Camera: Remidio smartphone fundus camera. 1659x2212px
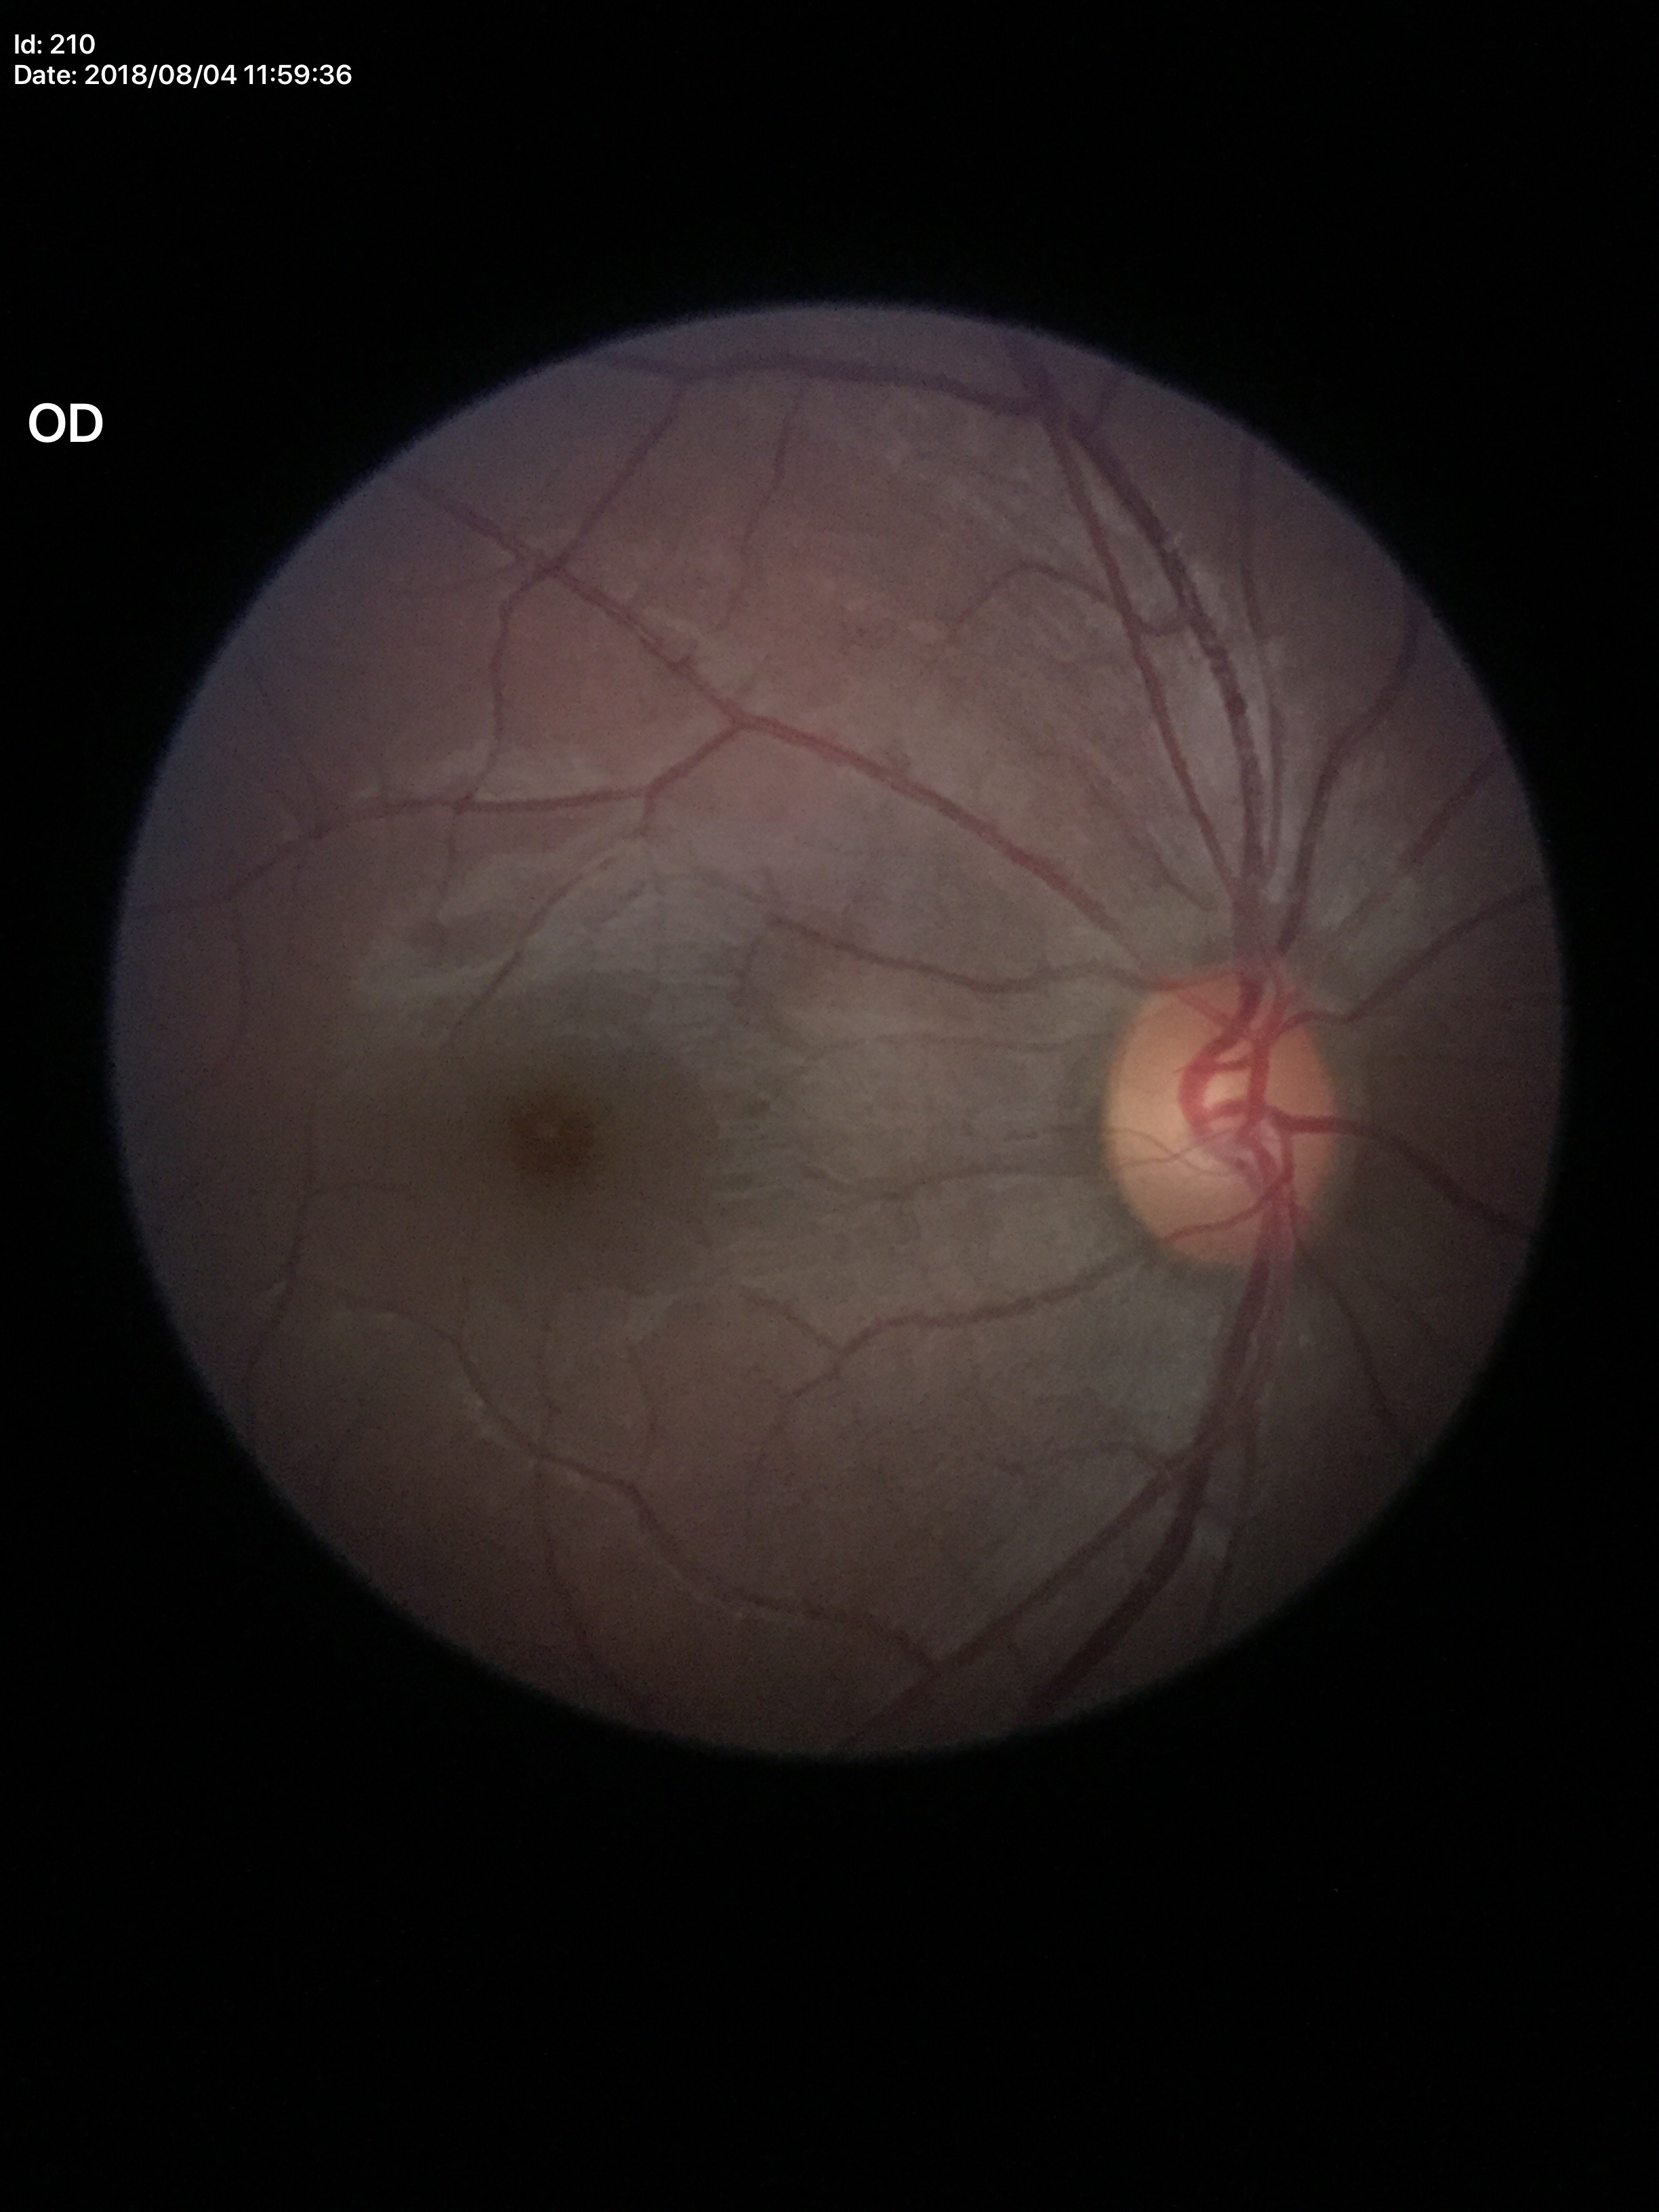 Negative for glaucoma suspicion (1/5 graders called glaucoma suspect). Vertical cup-to-disc ratio of 0.56.